DR severity per modified Davis staging, color fundus image, NIDEK AFC-230, nonmydriatic fundus photograph, 45-degree field of view, 848 by 848 pixels:
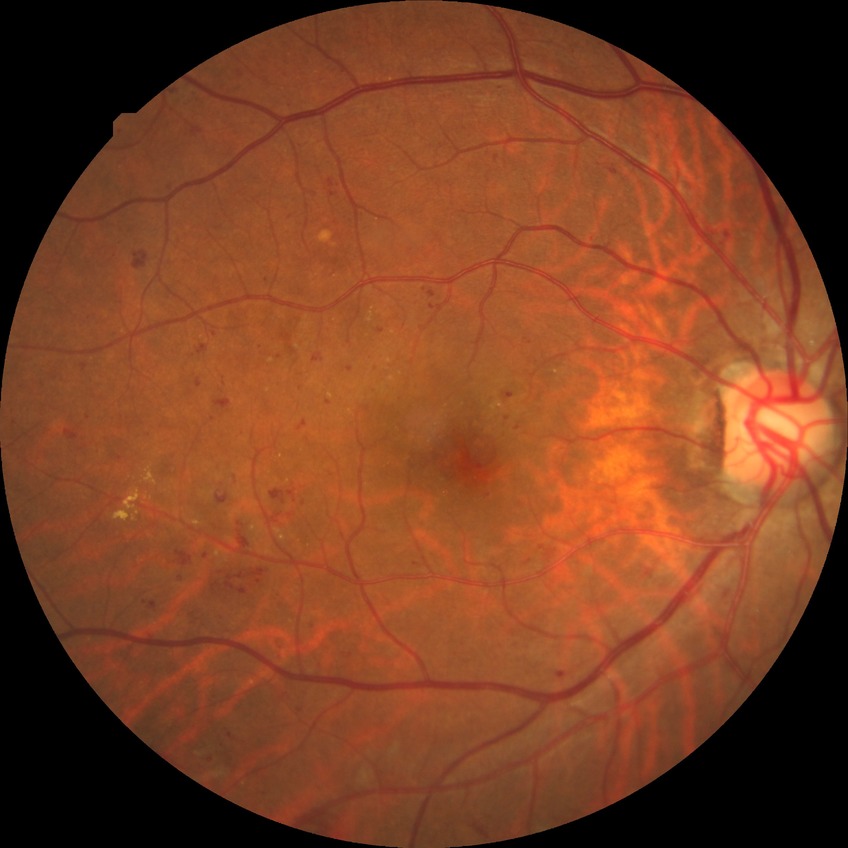 retinopathy grade: pre-proliferative diabetic retinopathy.